848x848px
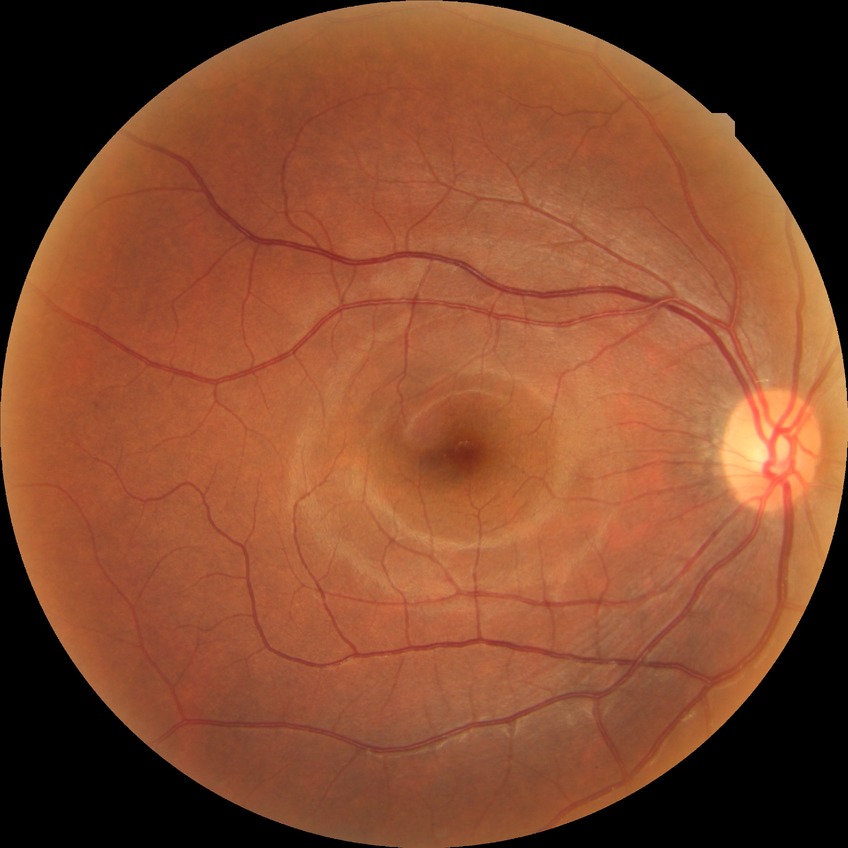
Davis grade: NDR.